100° field of view (Phoenix ICON). 1240x1240. Pediatric wide-field fundus photograph: 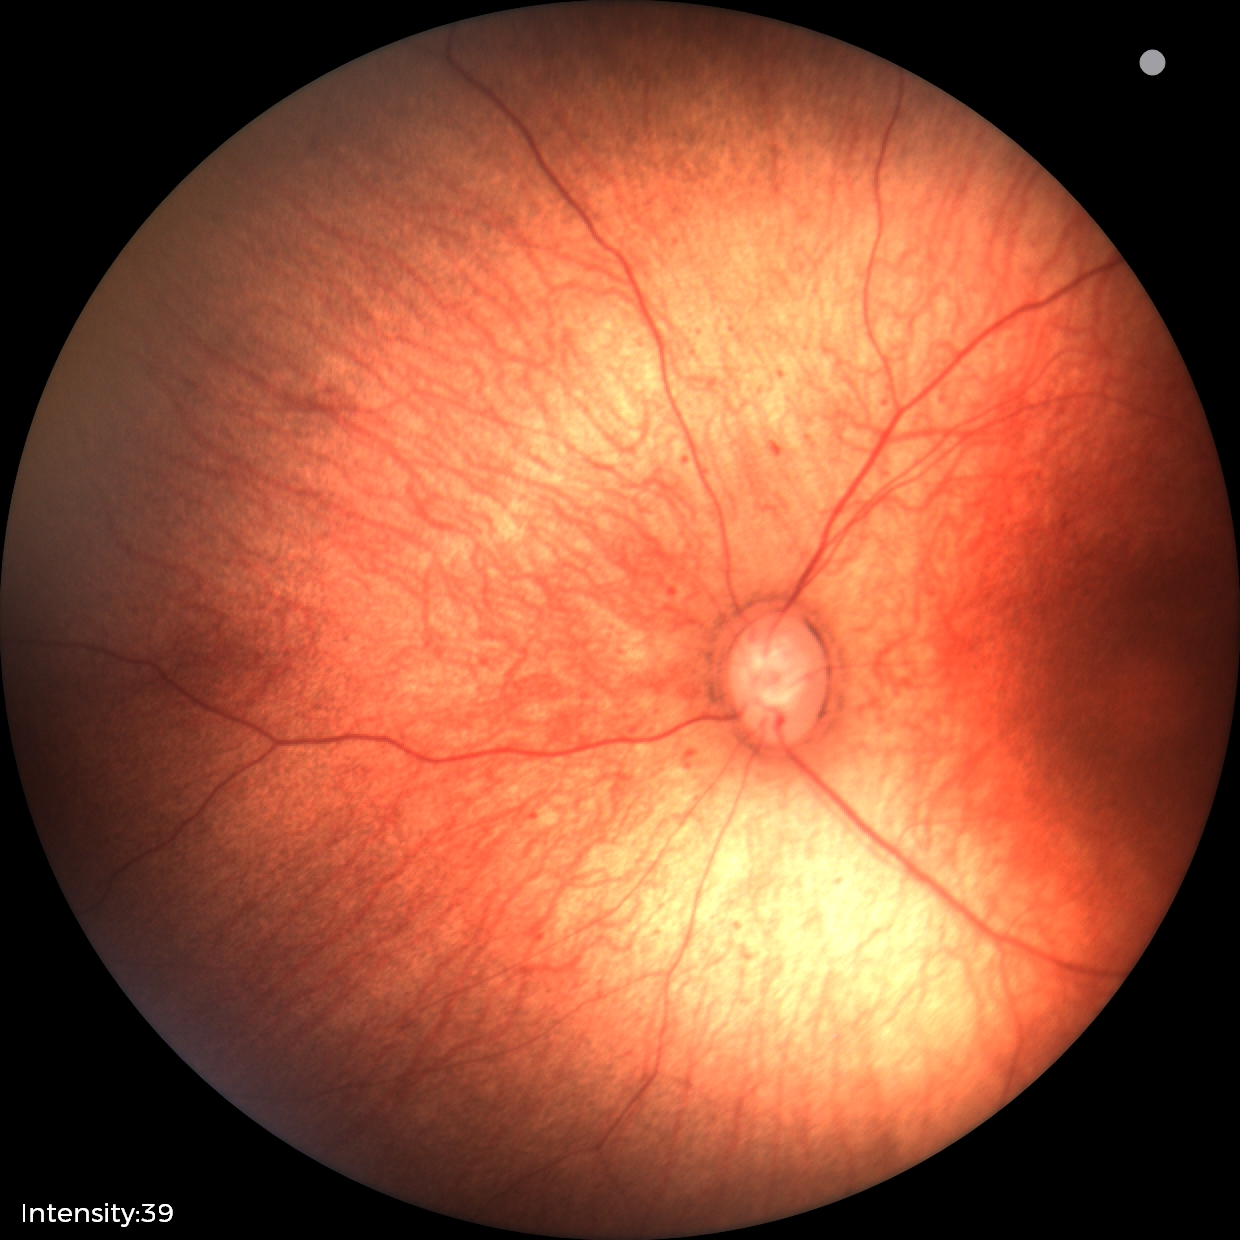
Impression = no abnormalities.